Graded on the modified Davis scale · NIDEK AFC-230 · 848 by 848 pixels
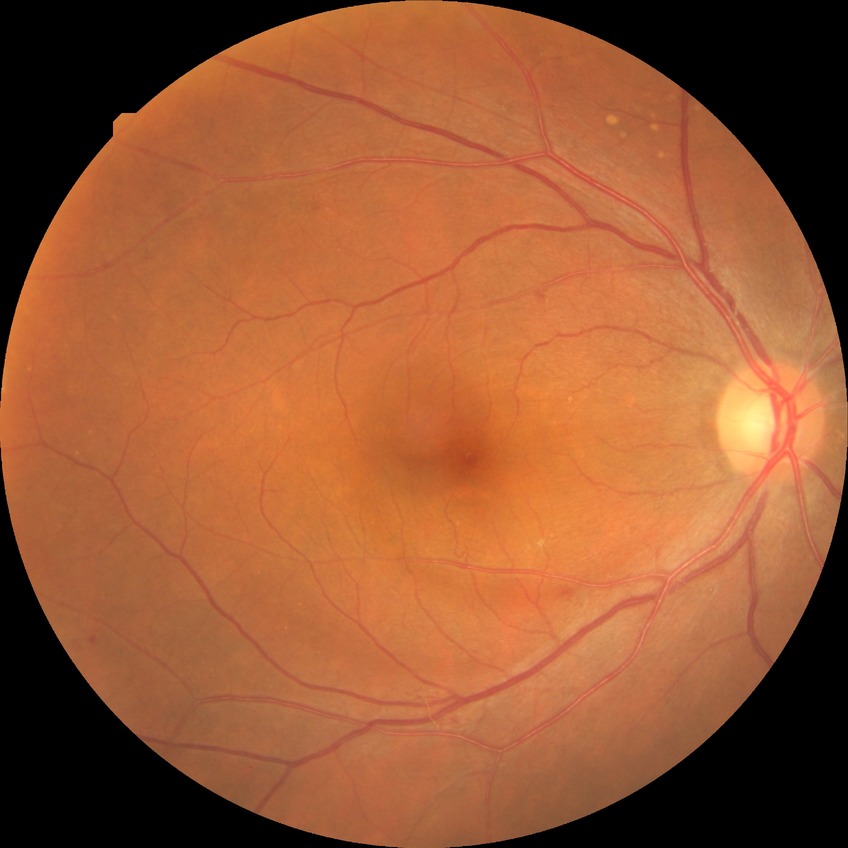
DR grade: SDR.